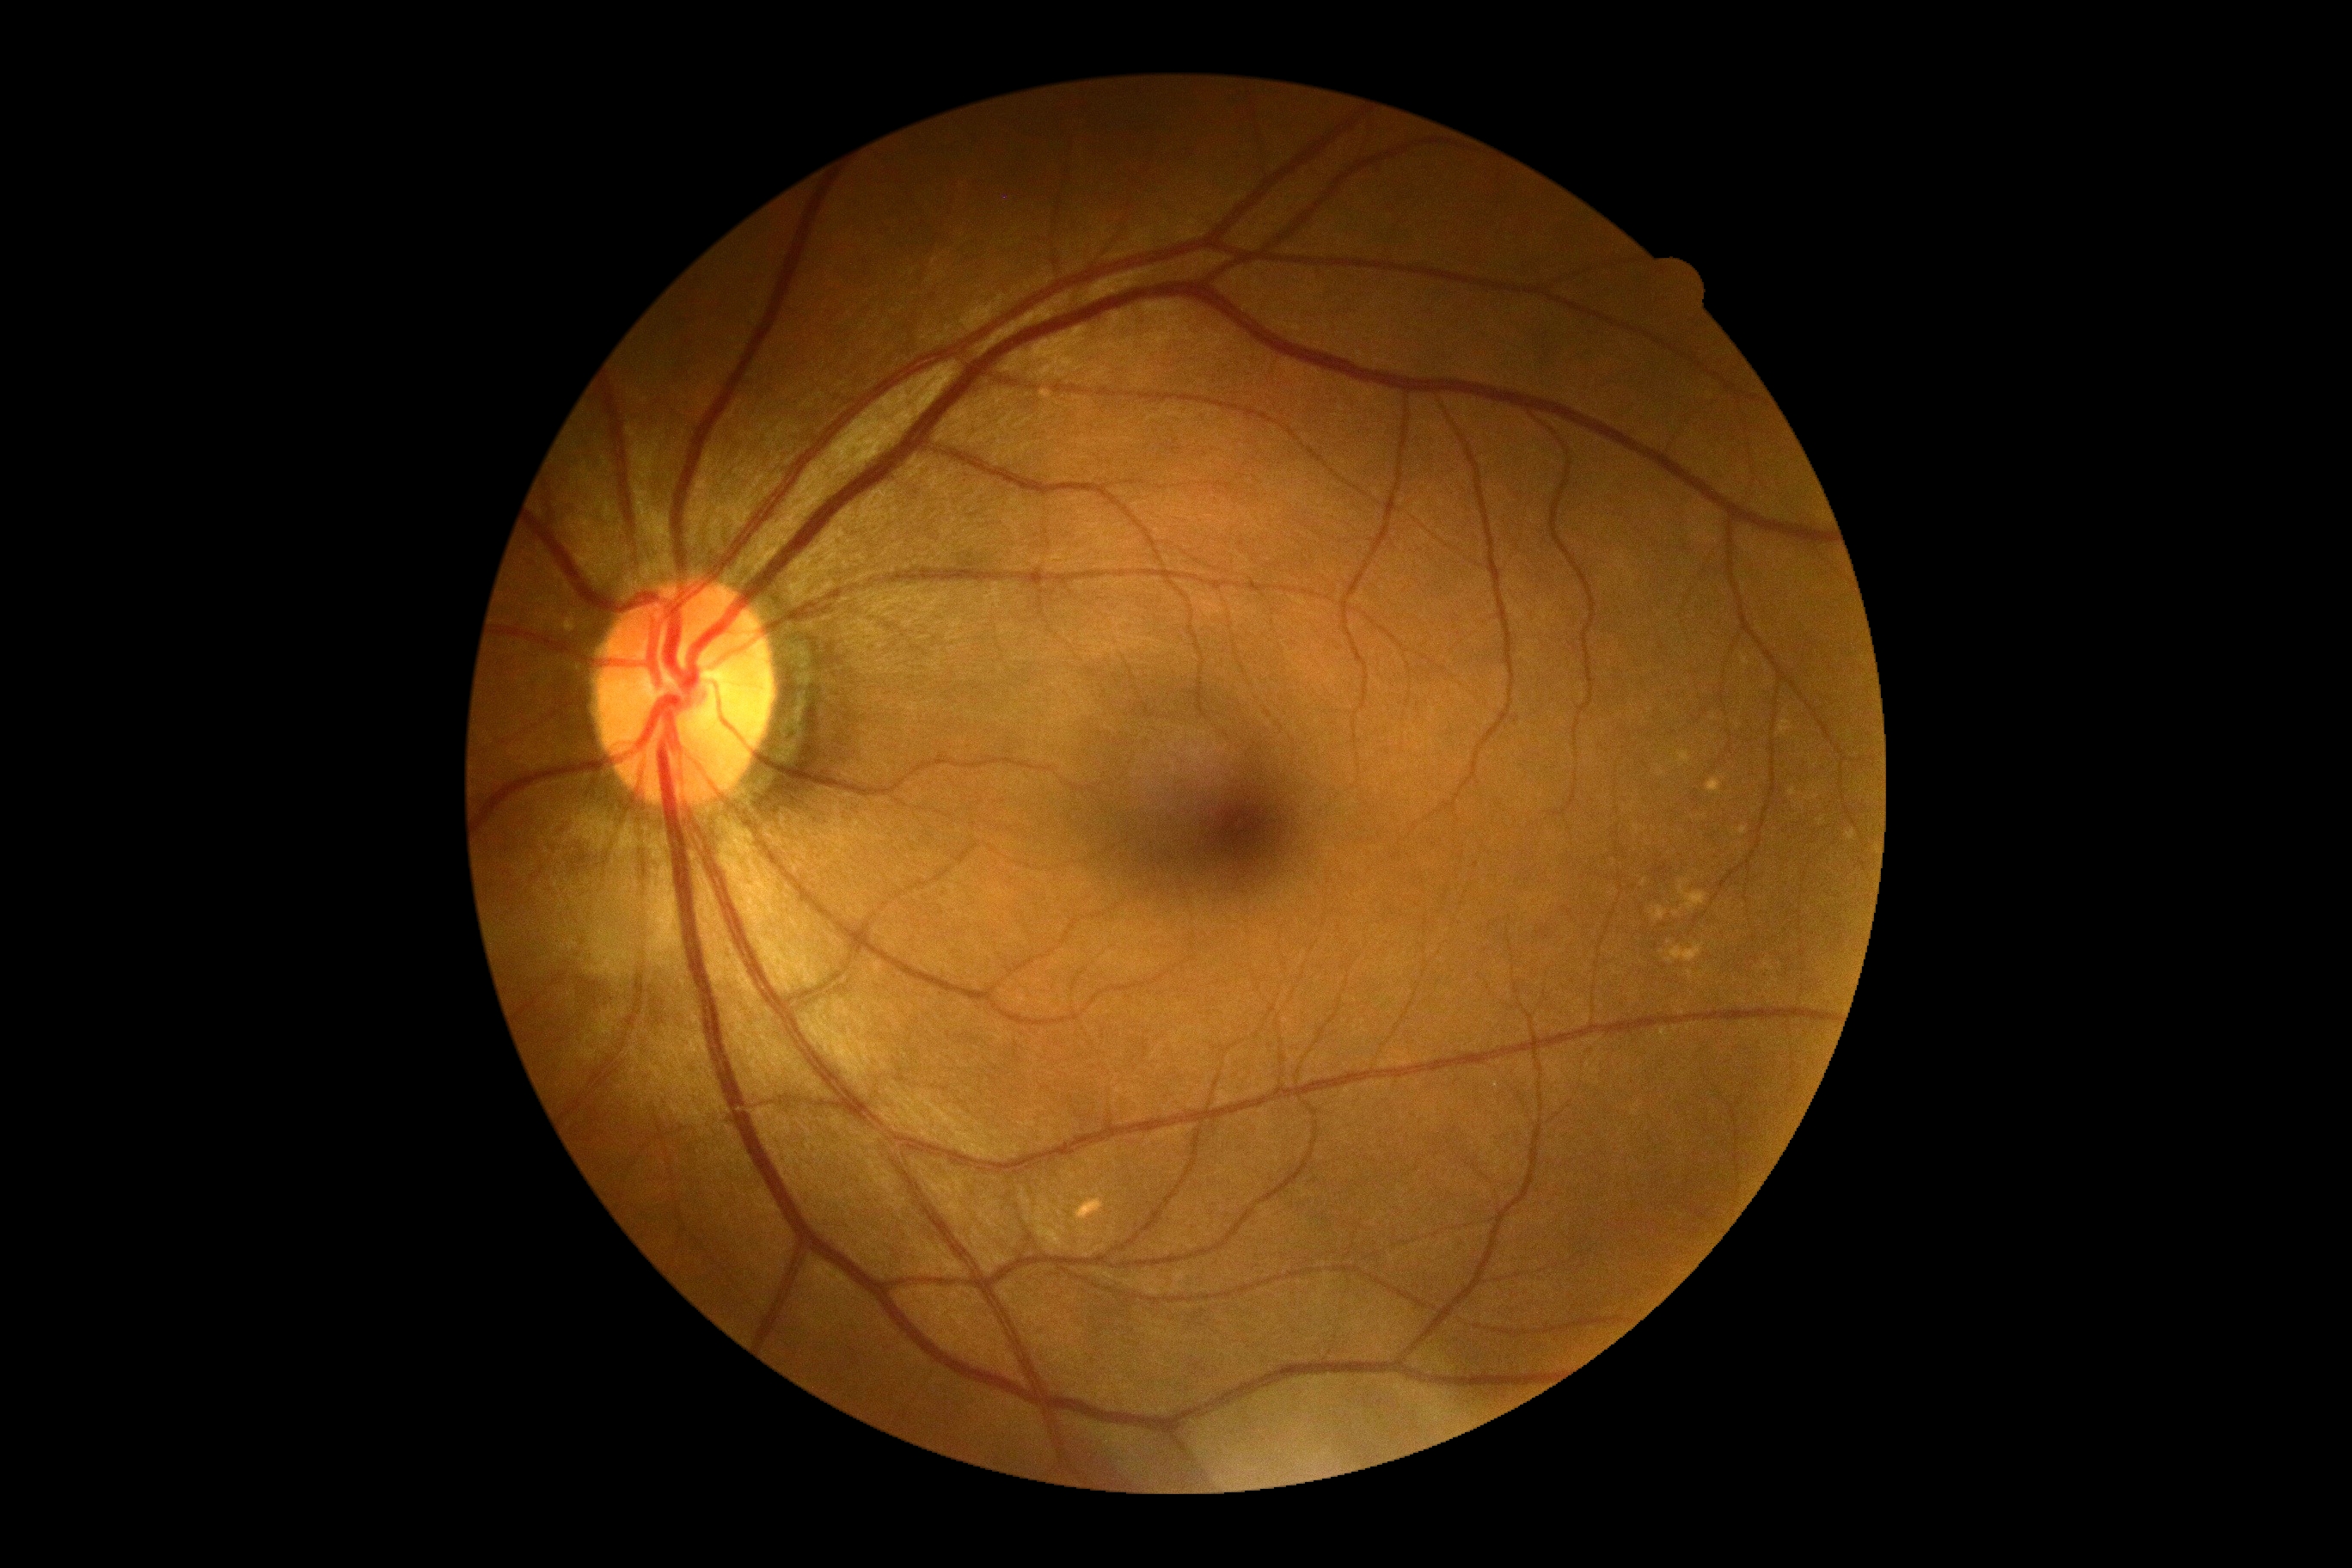
DR: no apparent diabetic retinopathy (grade 0).